Image size 1380x1382
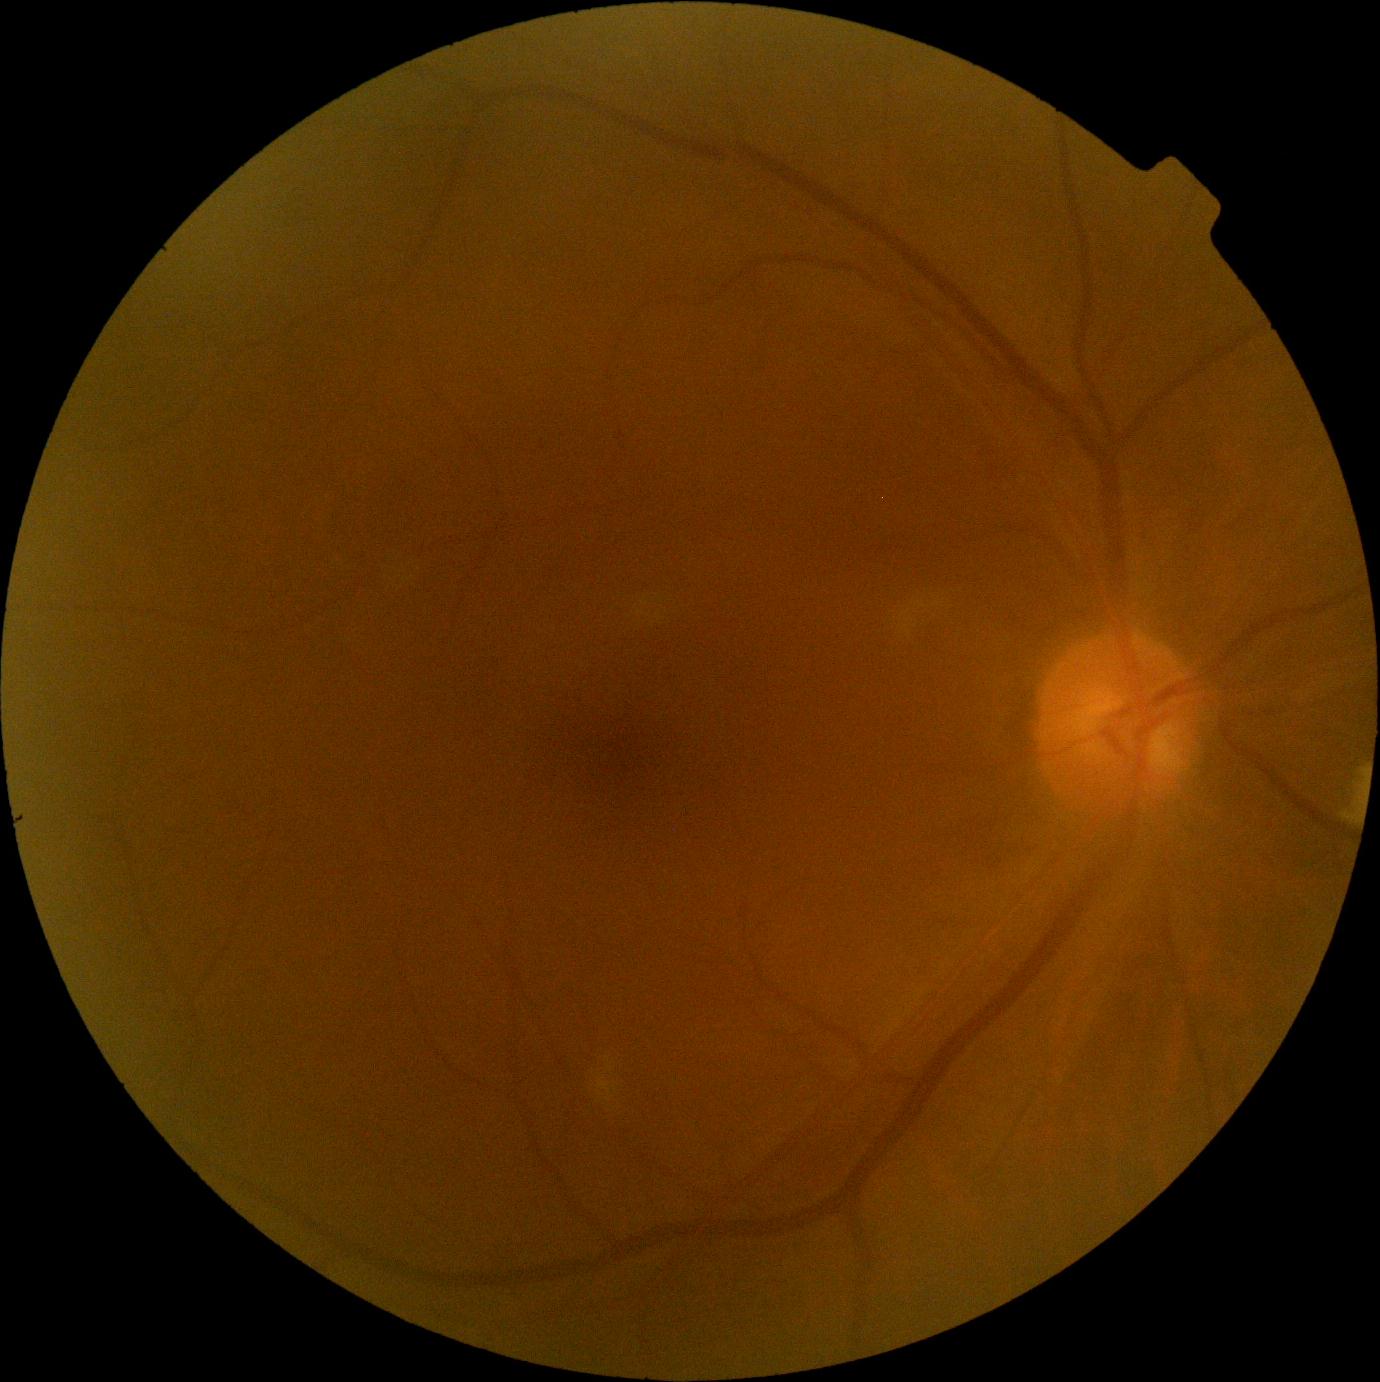

Findings:
• diabetic retinopathy (DR): 2 — more than just microaneurysms but less than severe NPDR
• DR class: non-proliferative diabetic retinopathy